Infant wide-field retinal image — 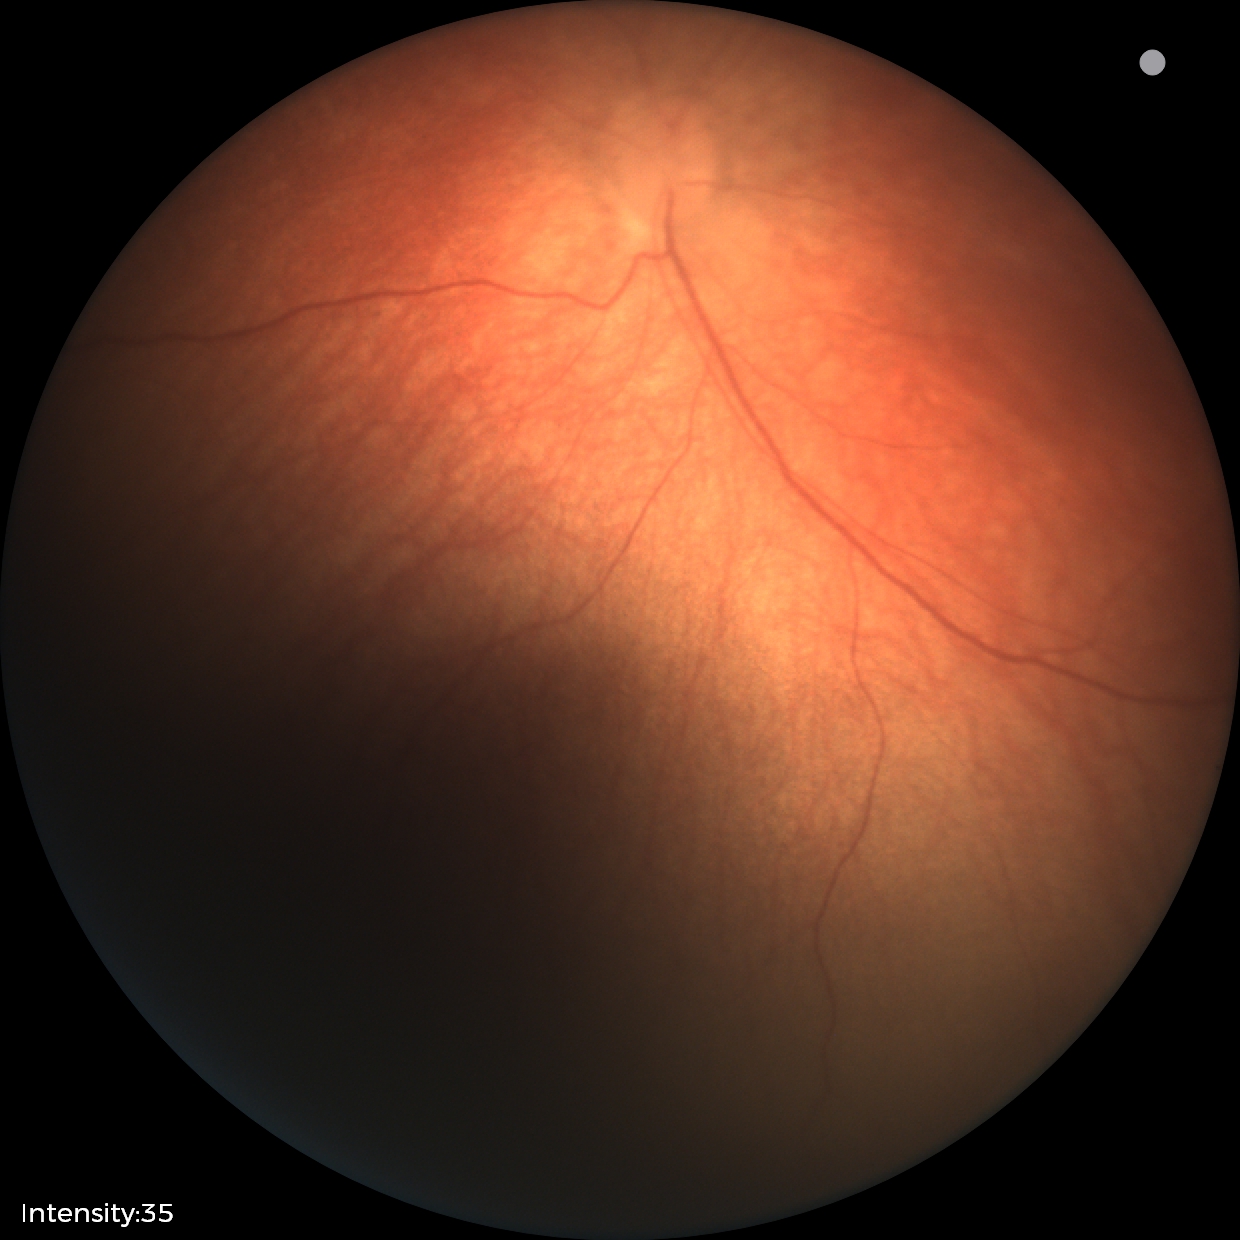

Normal screening examination.